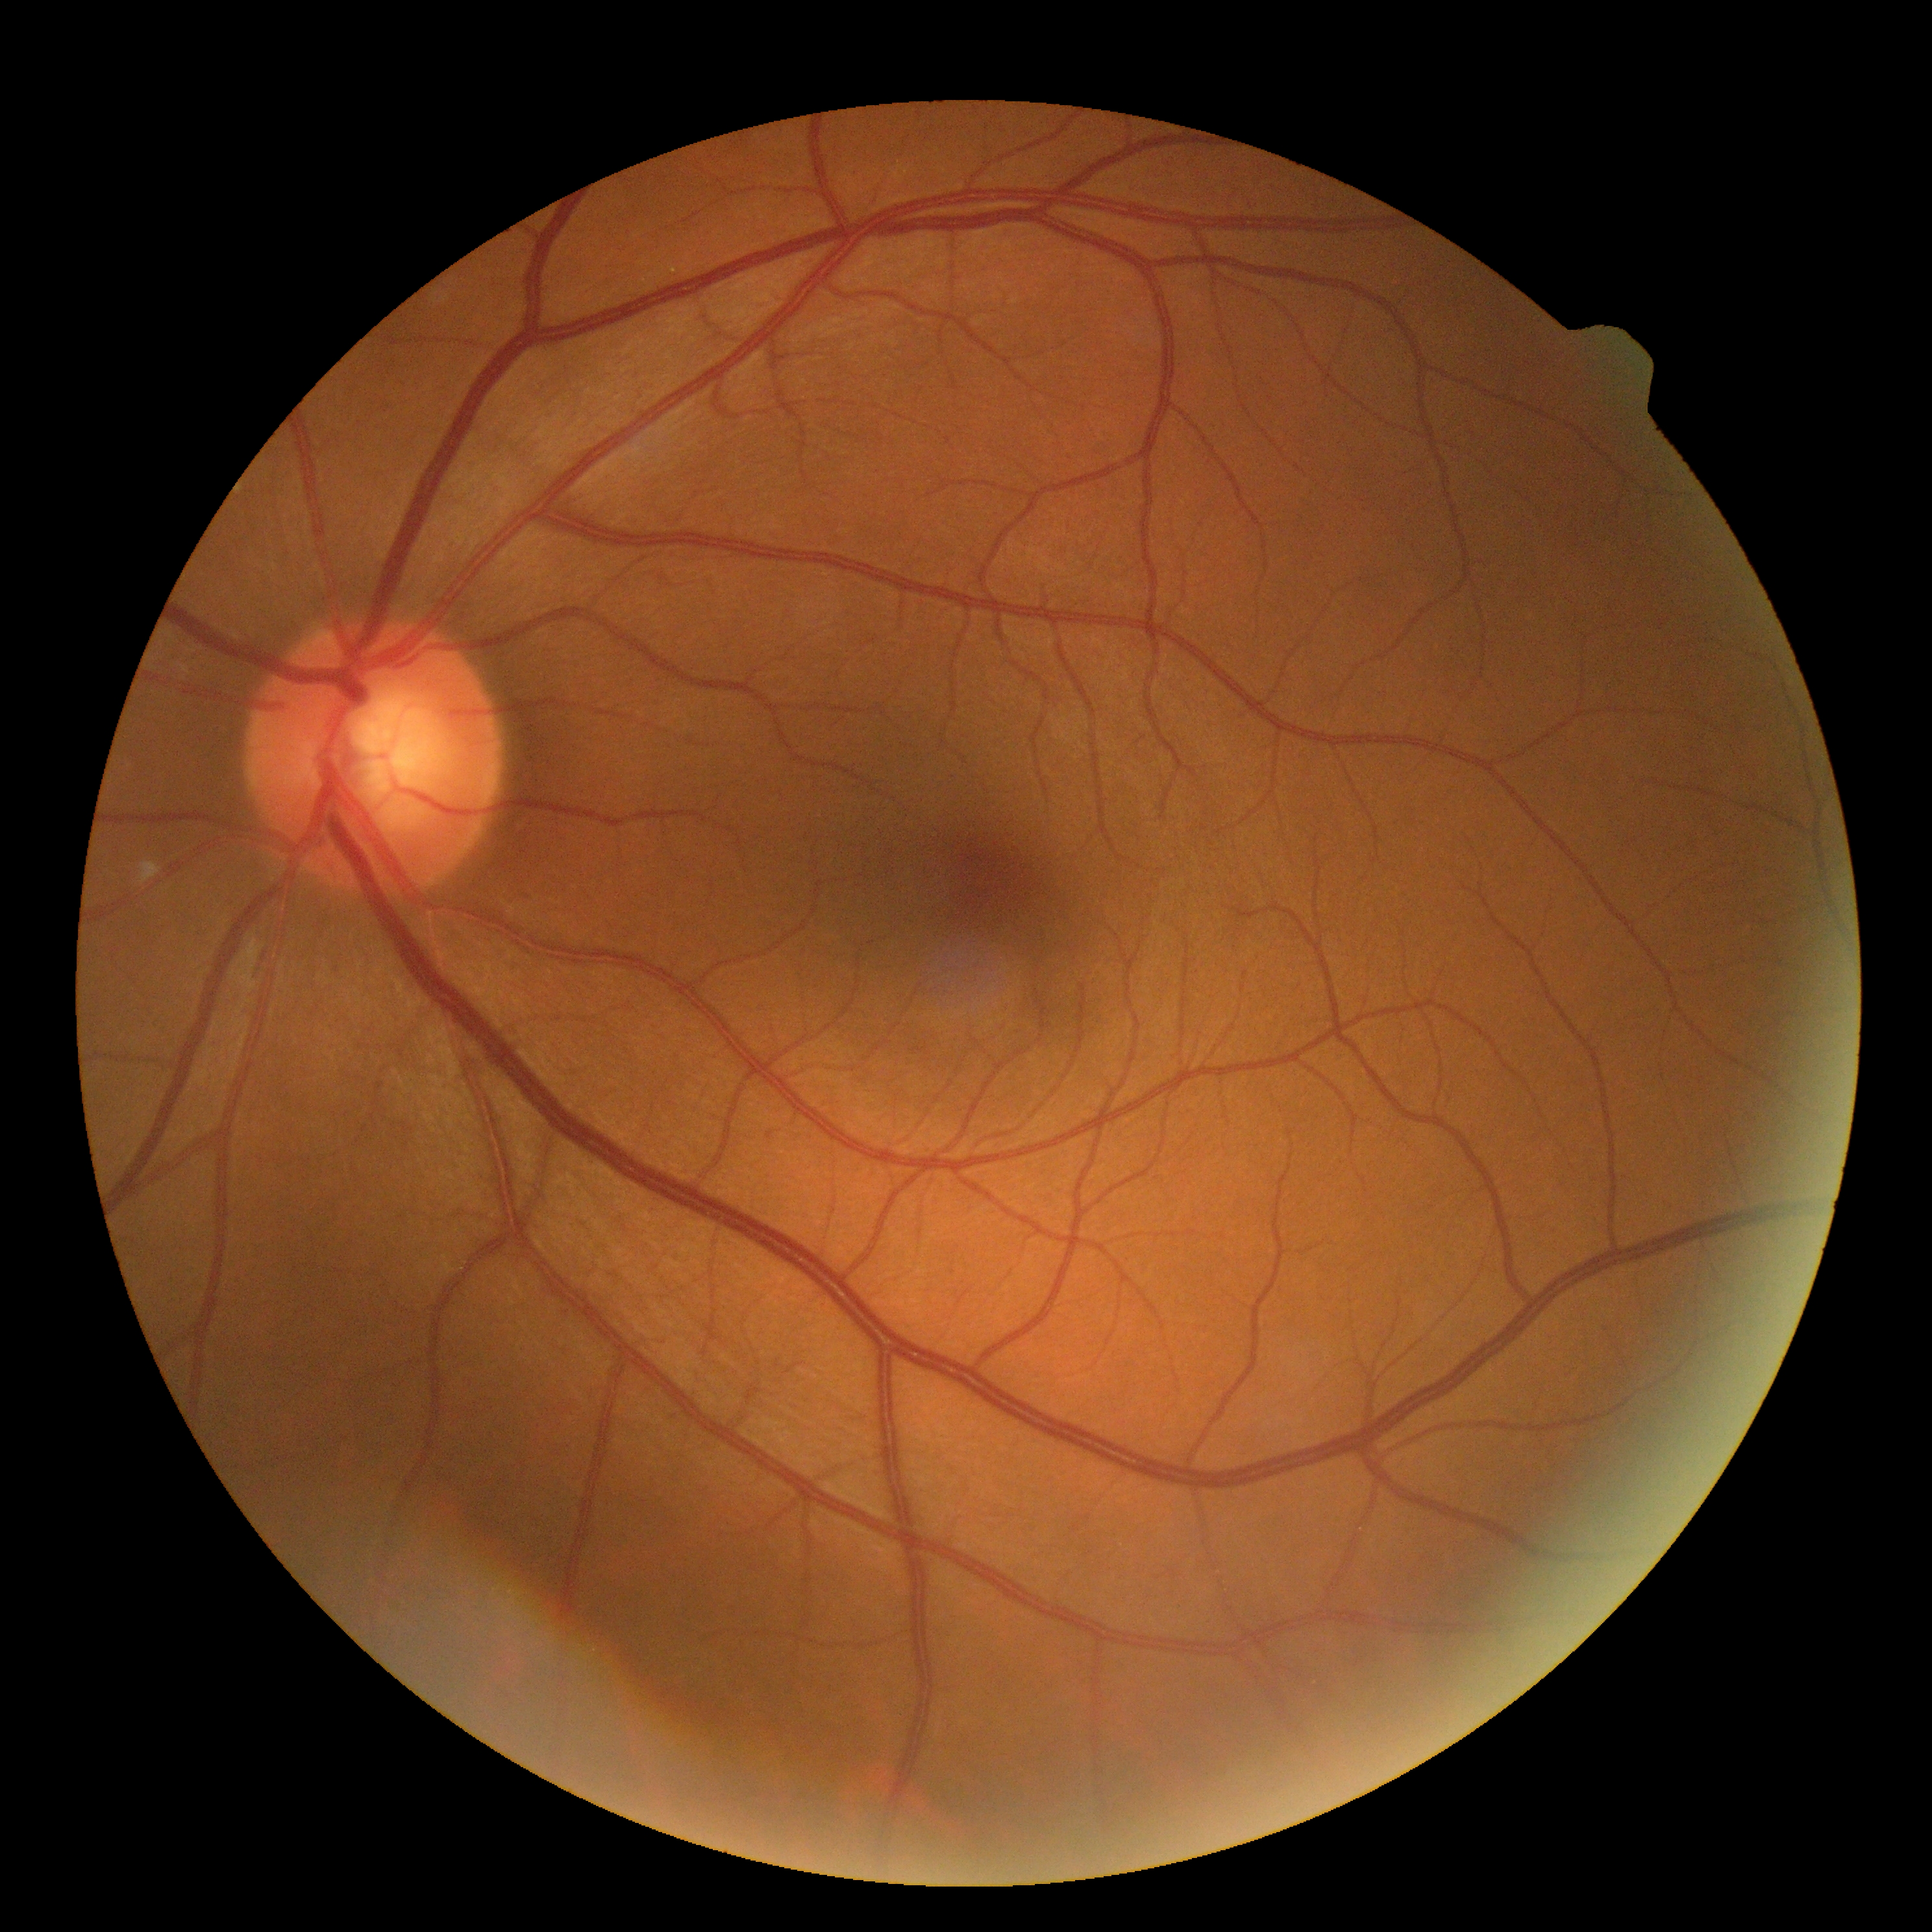 Diabetic retinopathy (DR) is grade 0 (no apparent retinopathy).